Fundus photo, 2352x1568, 45-degree field of view: 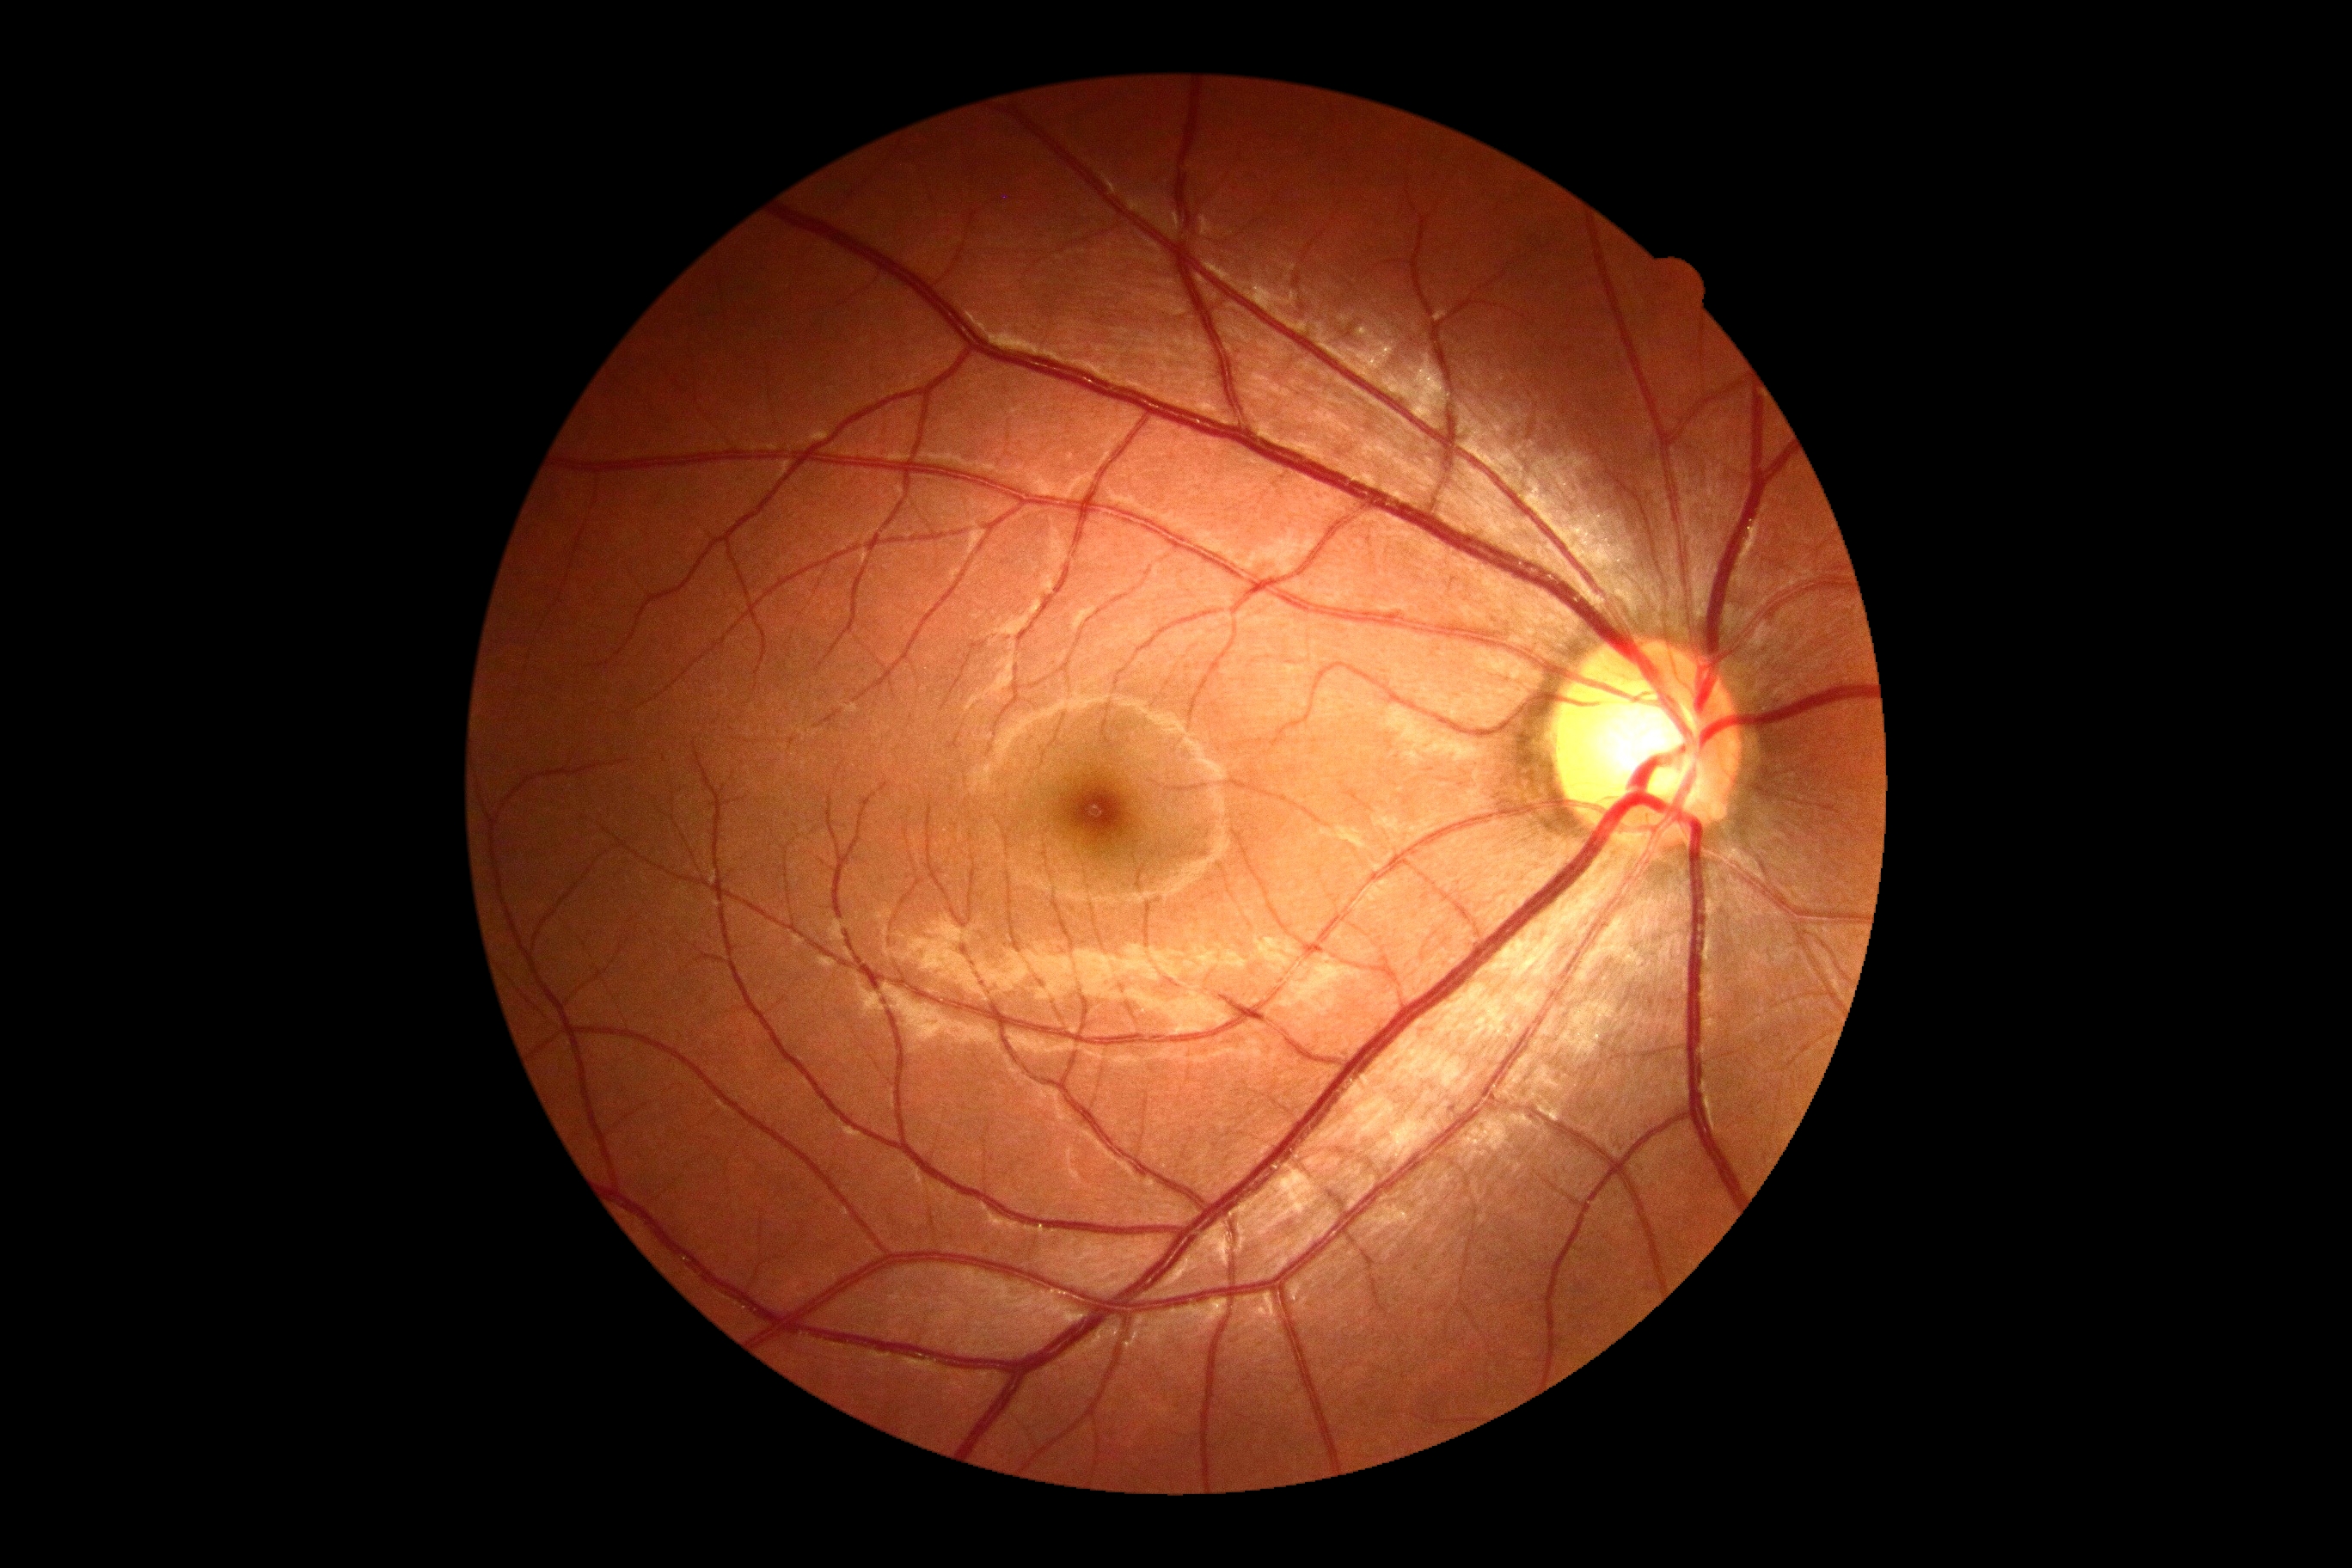

Findings:
– DR severity — grade 0 (no apparent retinopathy)